Wide-field fundus photograph of an infant:
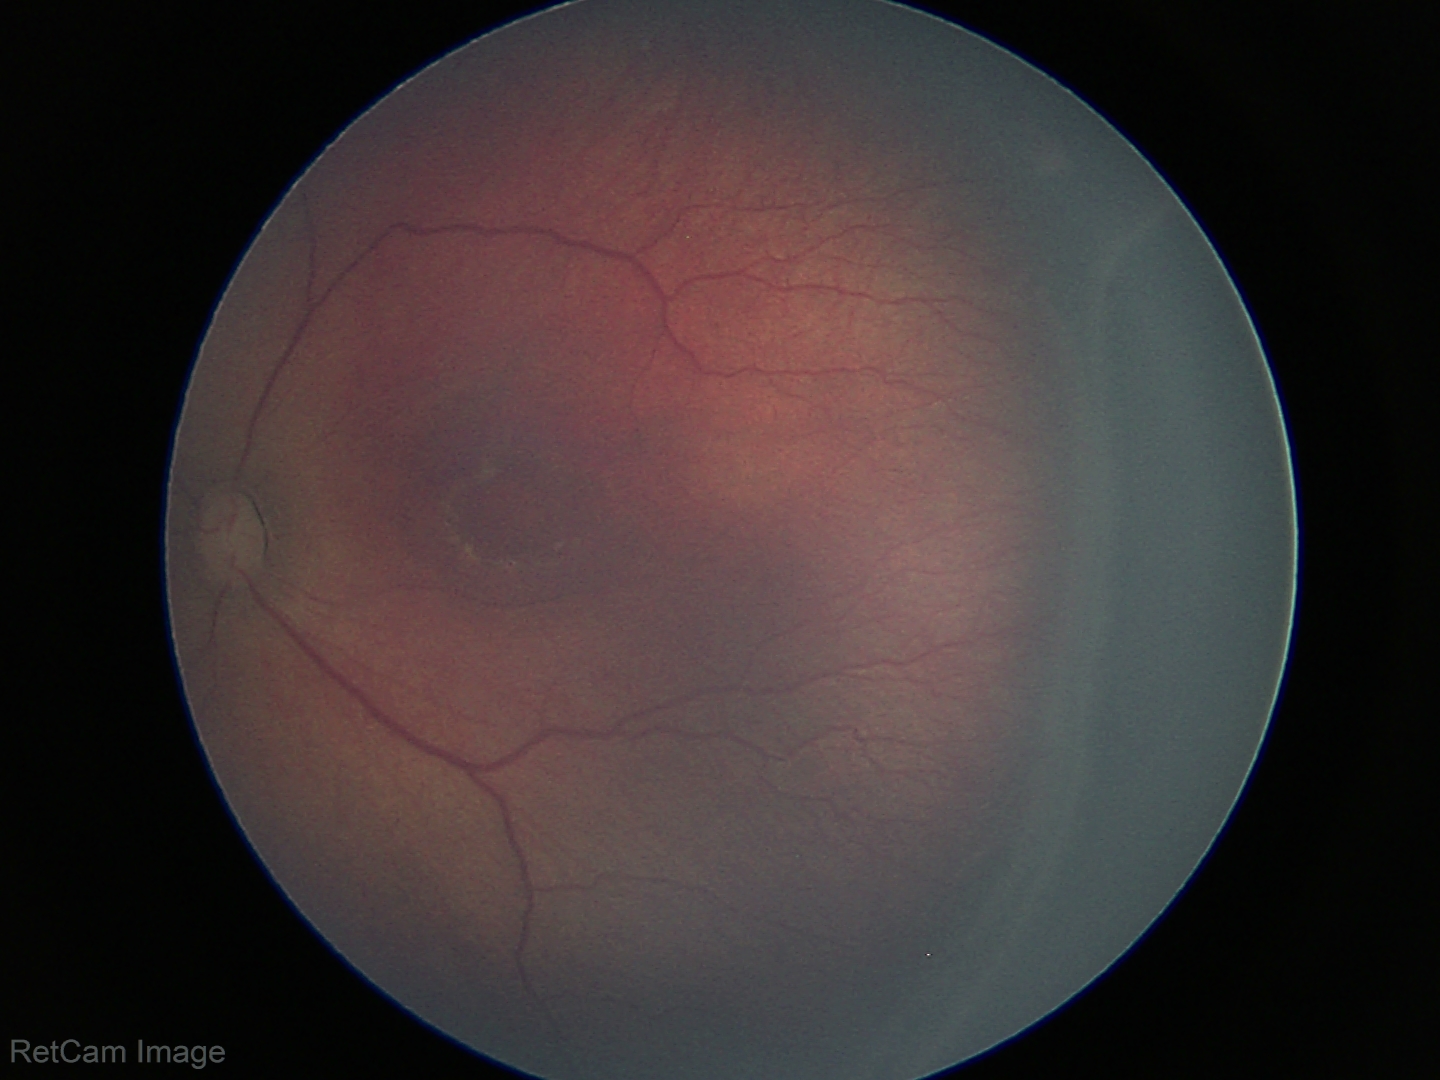 Series diagnosed as ROP stage 3.
No plus disease.